Phoenix ICON wide-field infant fundus image · 1240x1240px
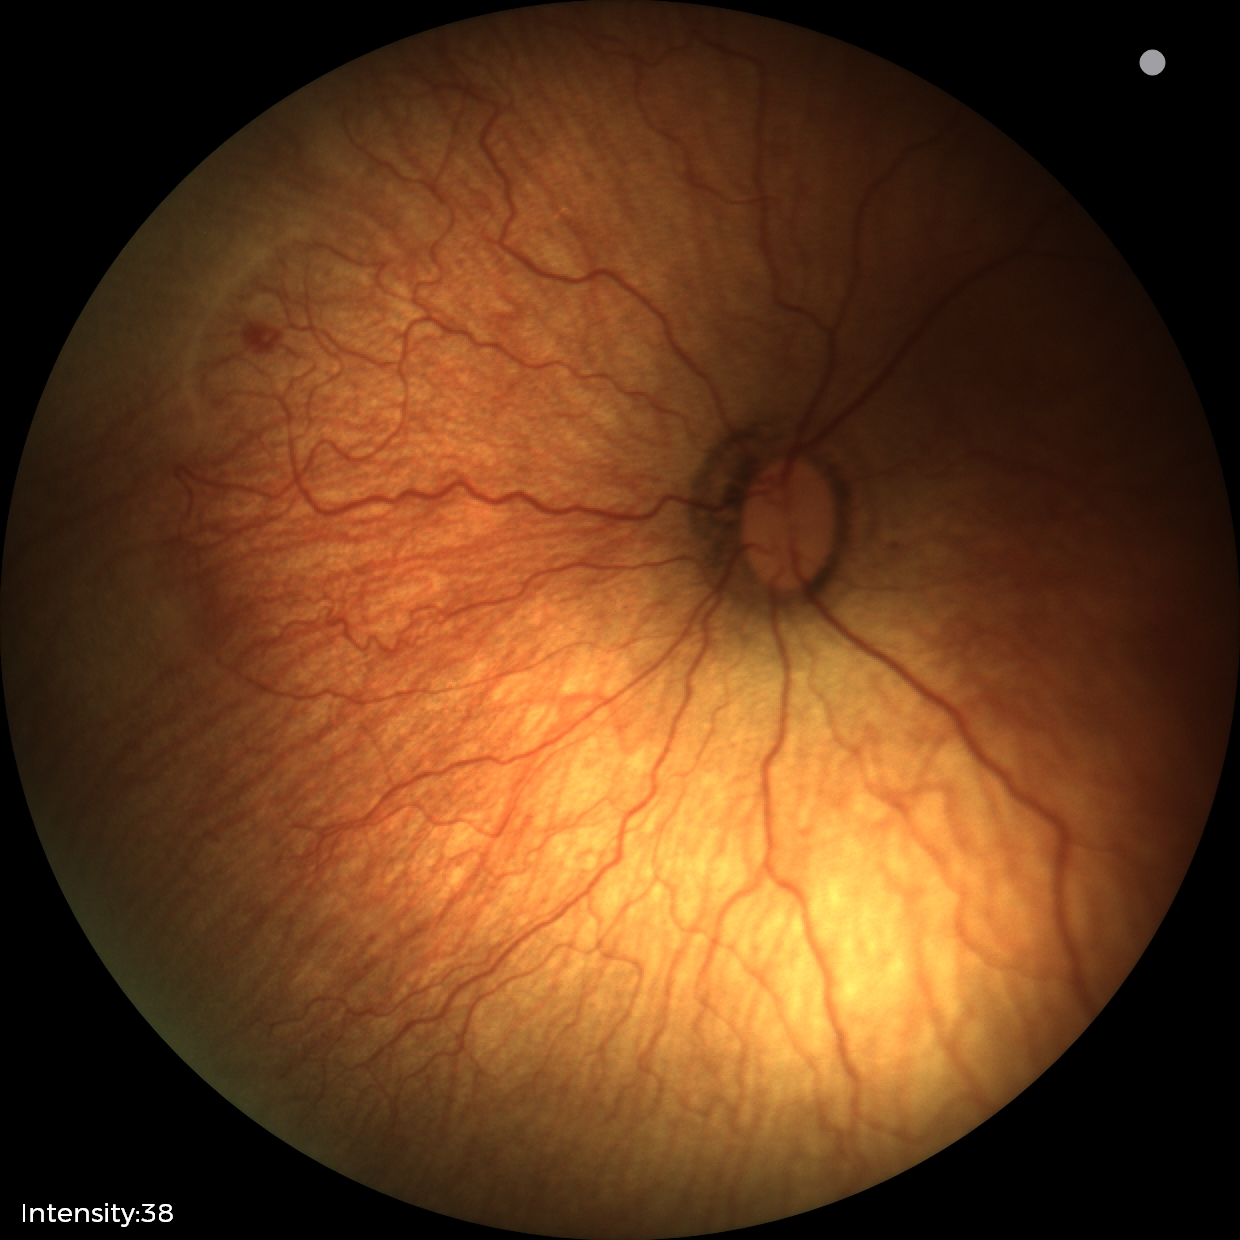
Screening examination consistent with retinopathy of prematurity stage 1. No plus disease.